Fundus photo:
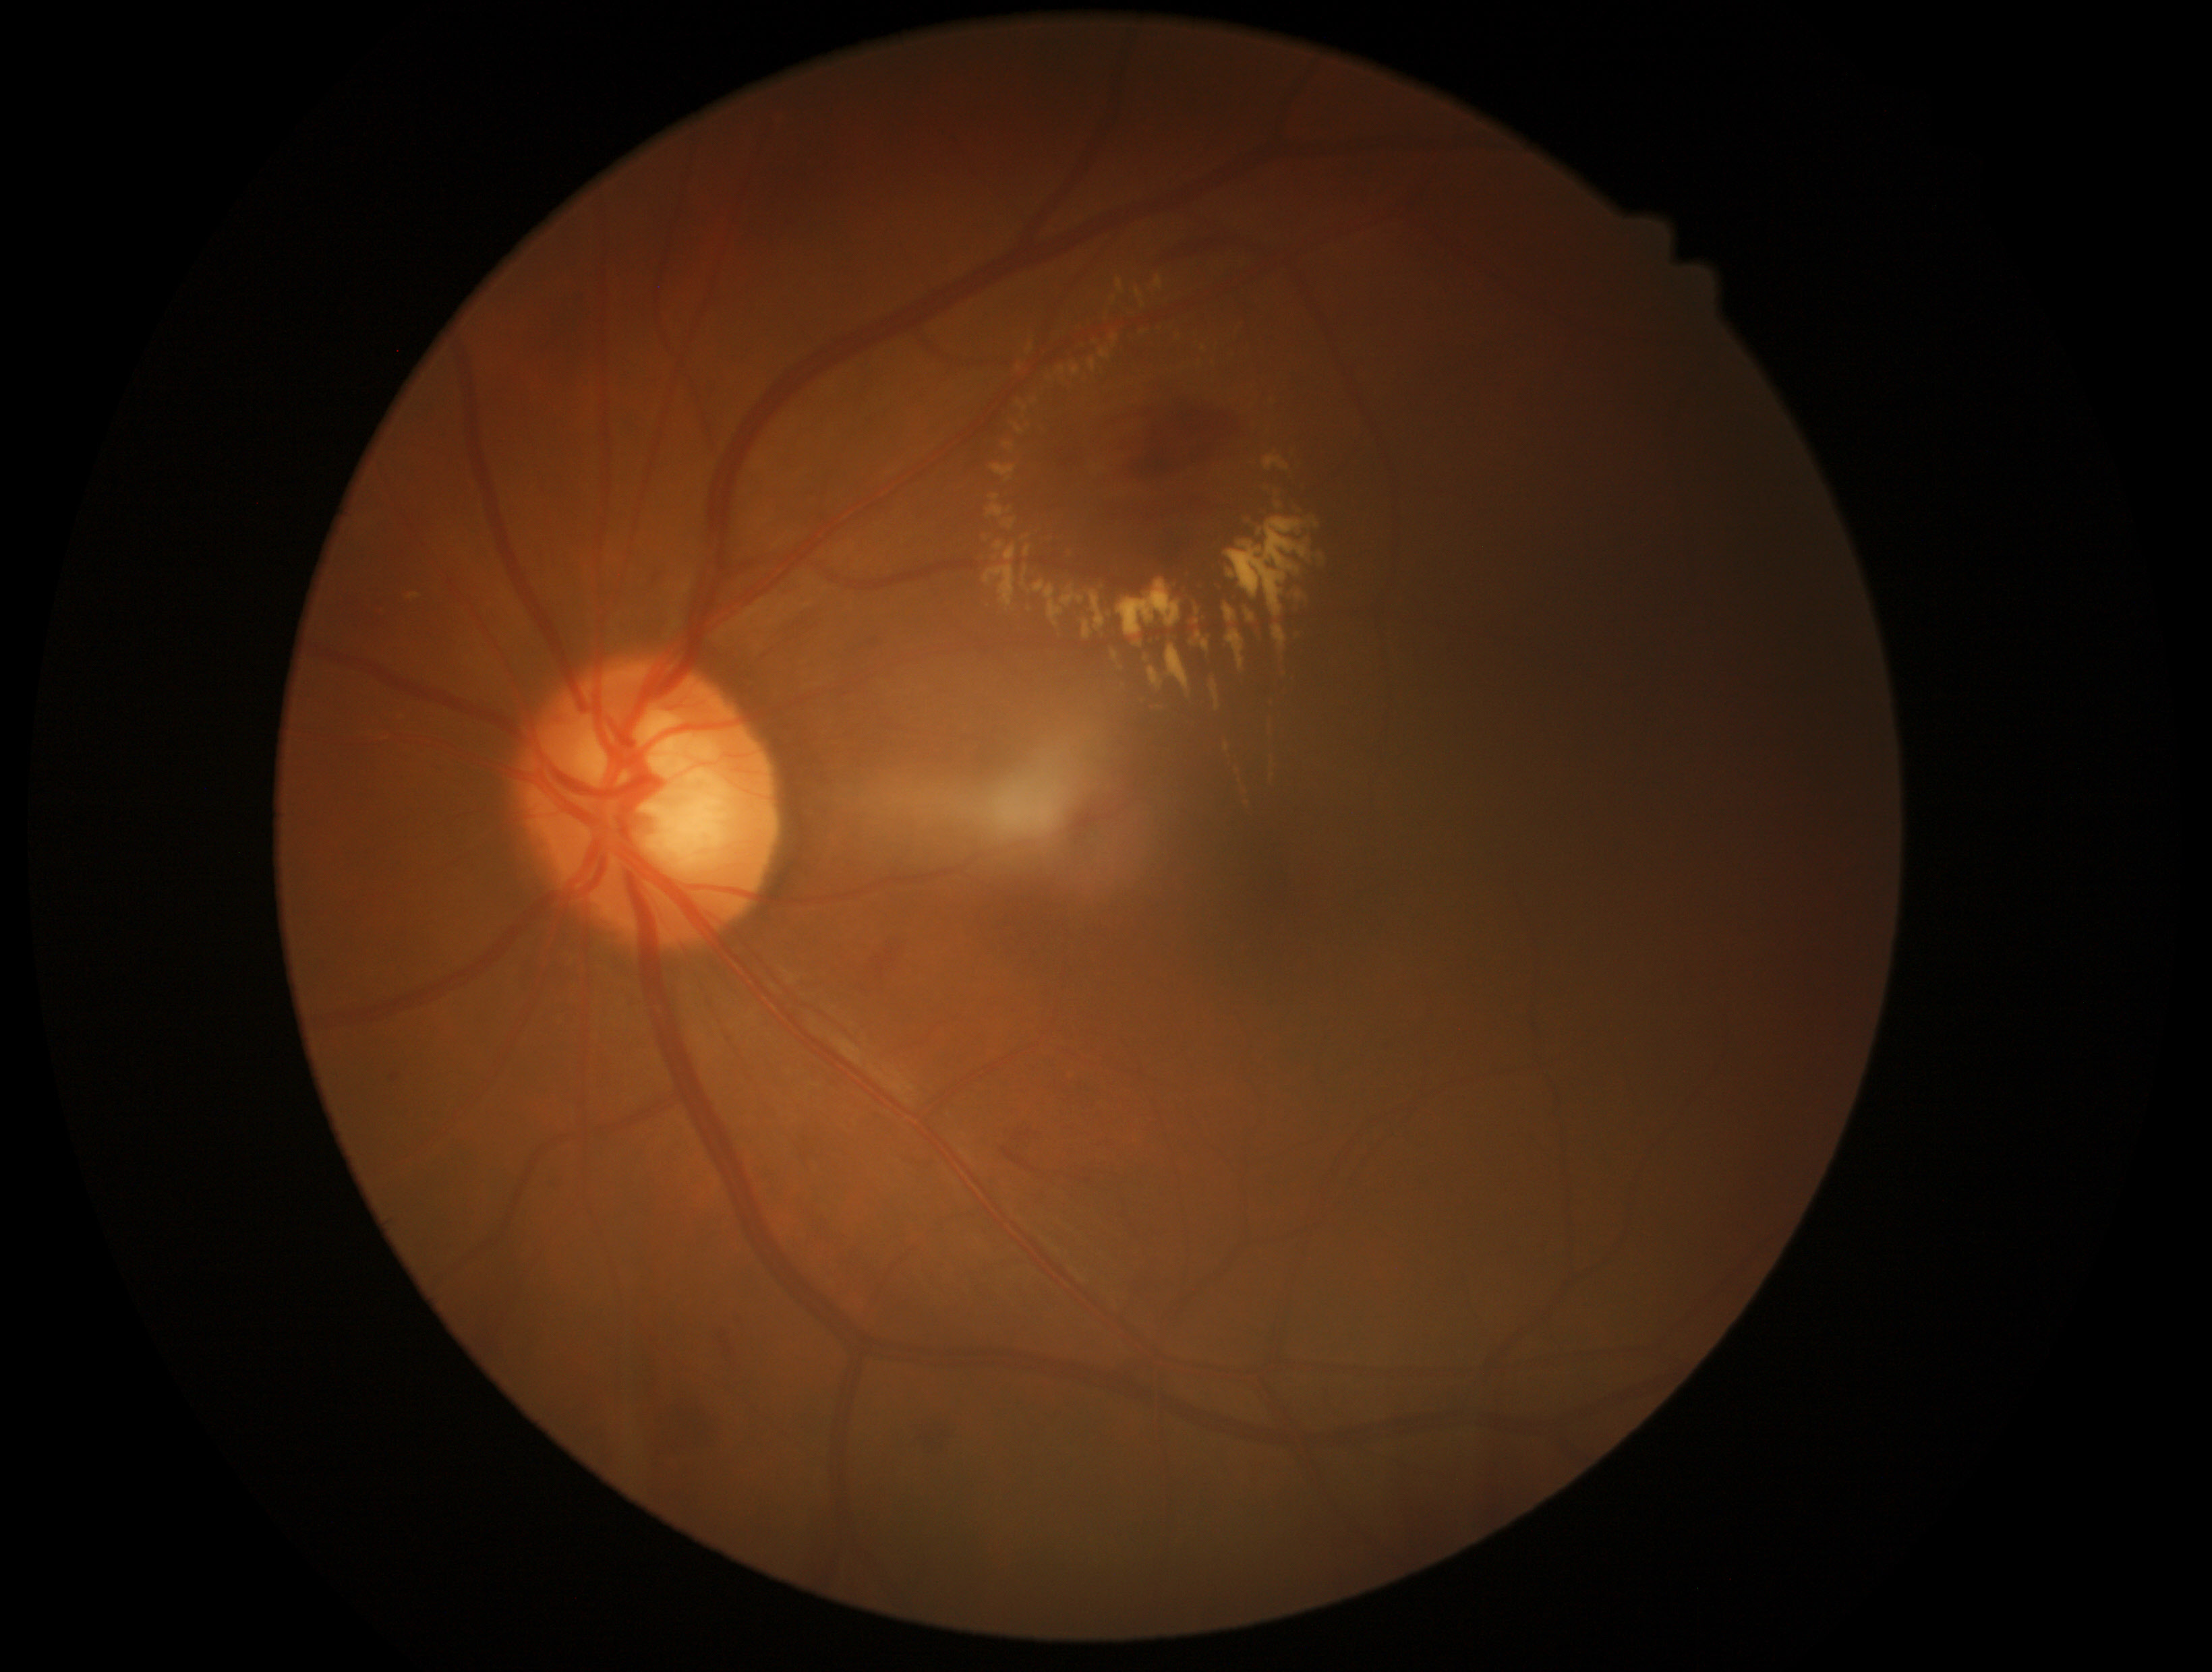 diabetic retinopathy (DR): grade 2 (moderate NPDR)